Retinal fundus photograph · modified Davis grading
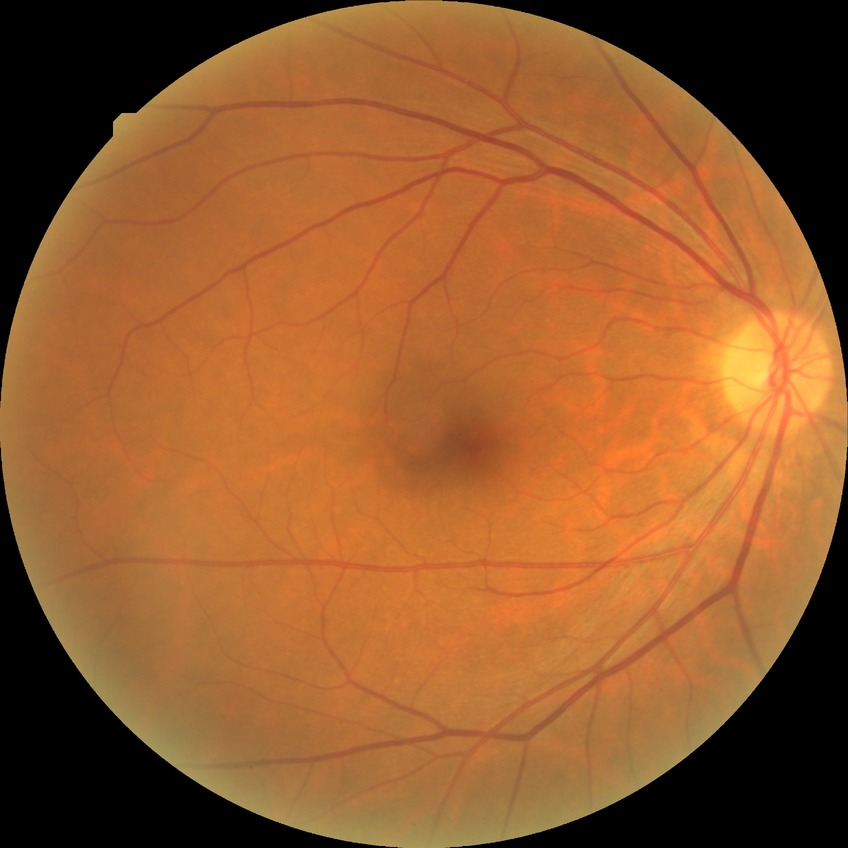
DR stage: NDR.
No apparent diabetic retinopathy.